848x848:
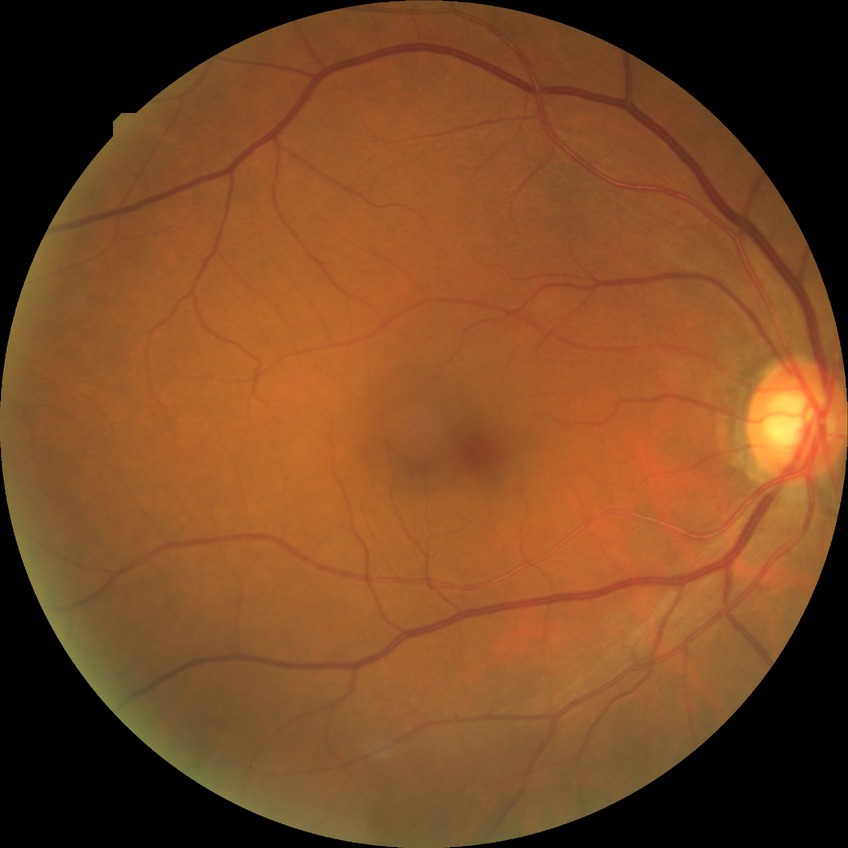

Diabetic retinopathy (DR): NDR (no diabetic retinopathy).